45° field of view. 2048x1536px:
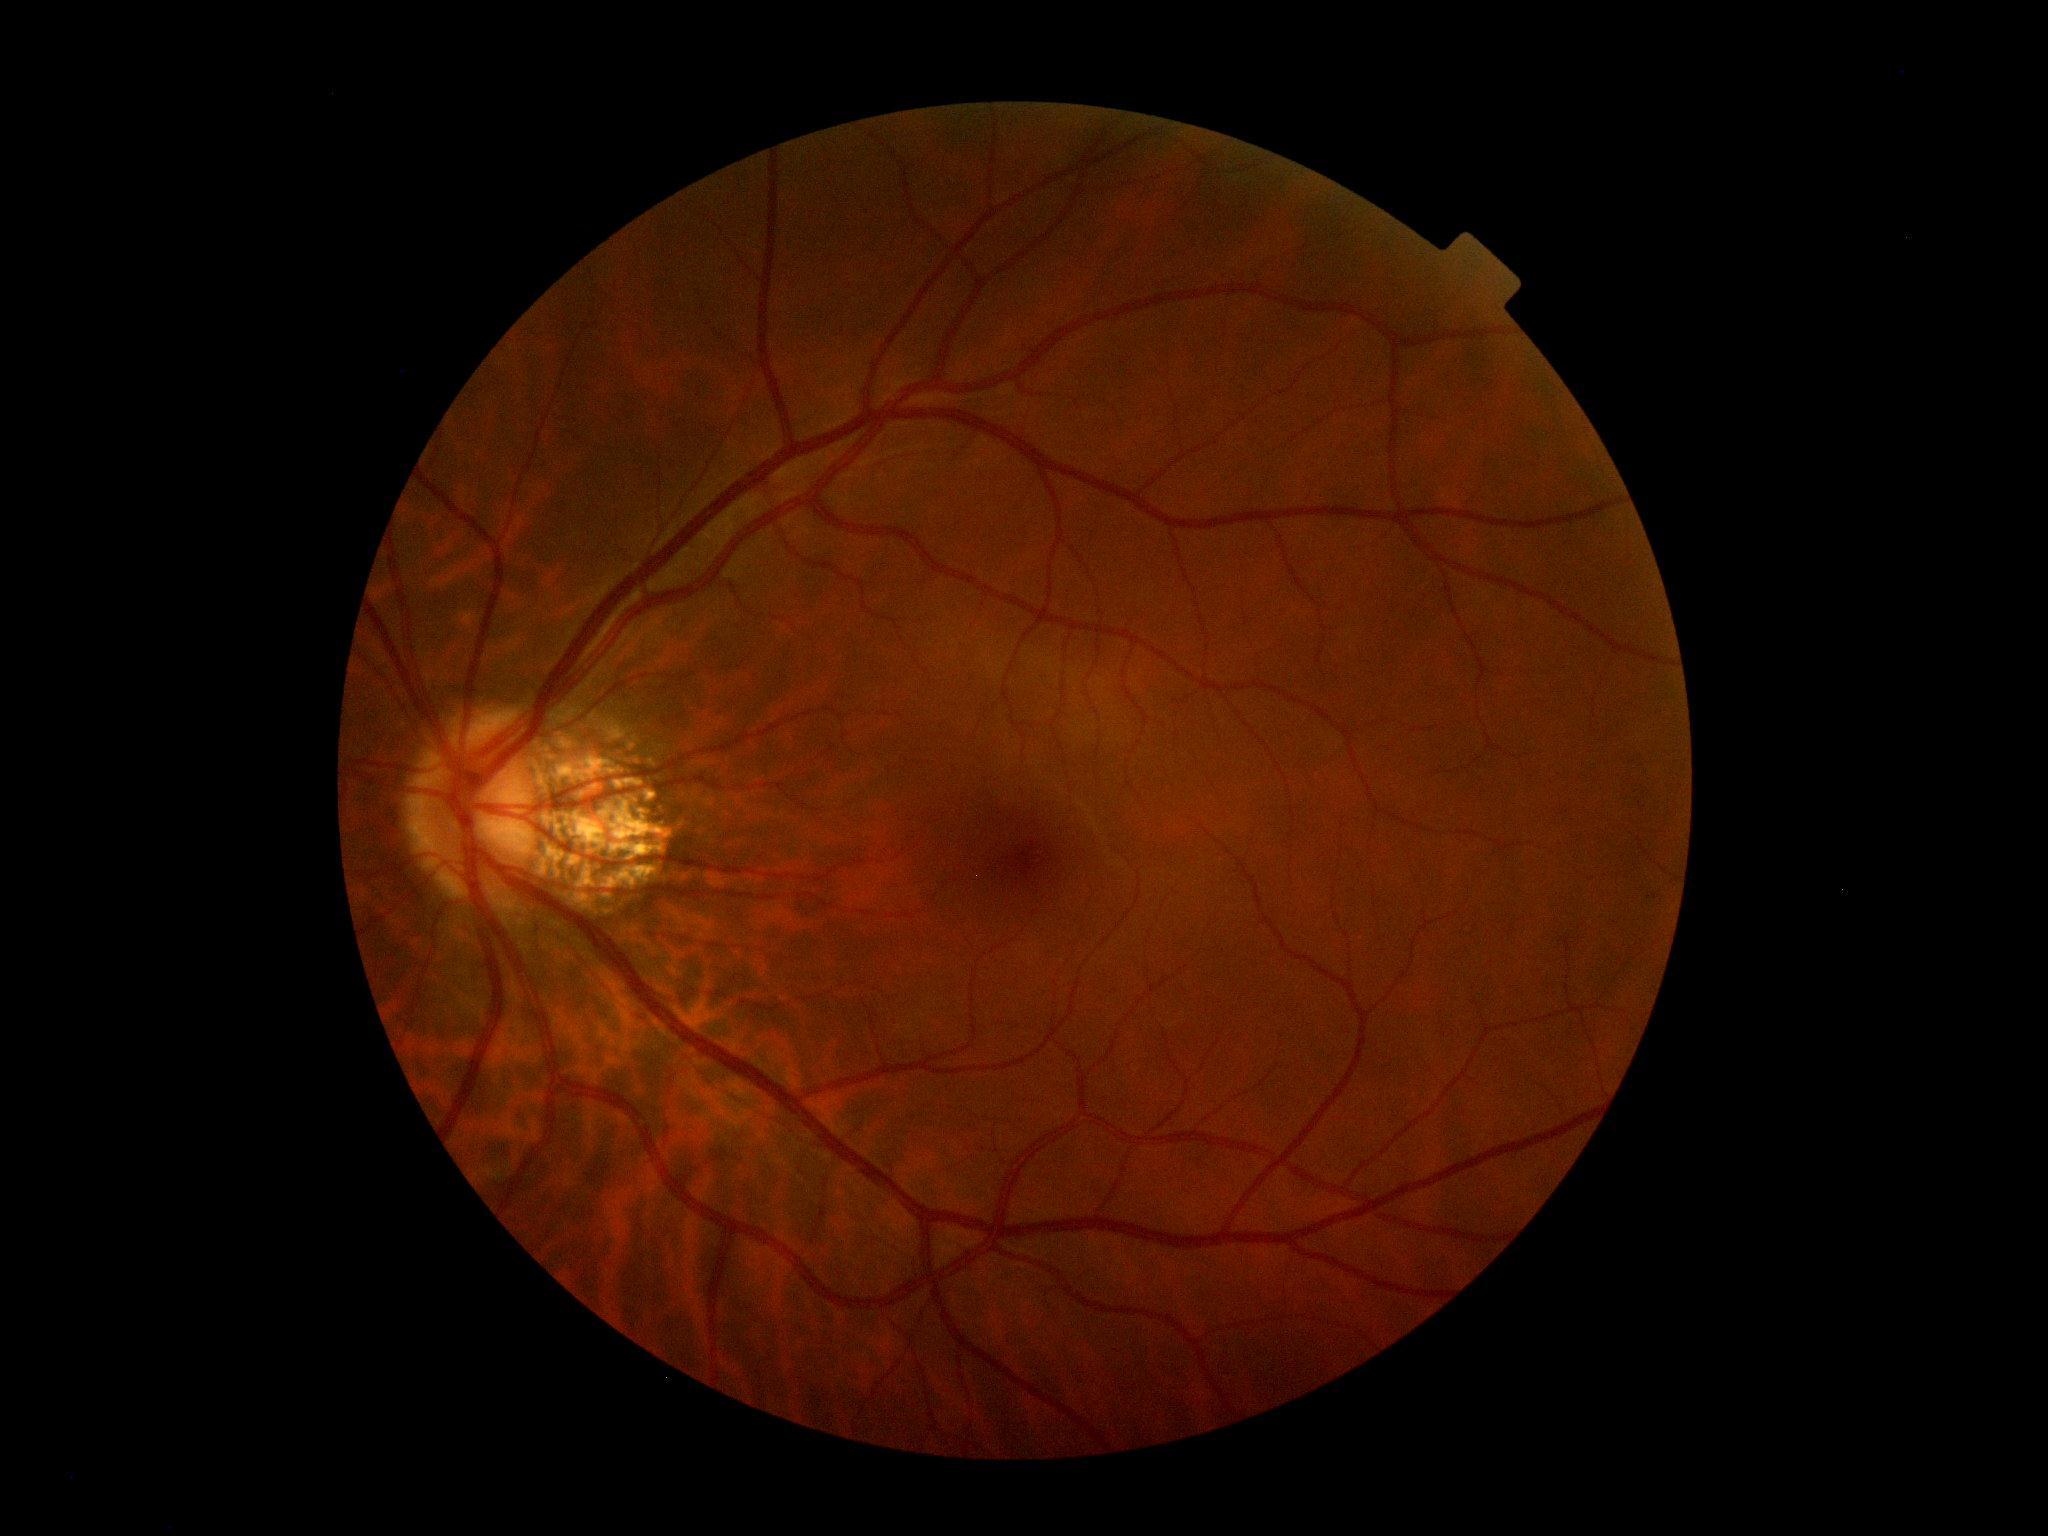
DR severity: 0/4.